45 degree fundus photograph. NIDEK AFC-230 fundus camera.
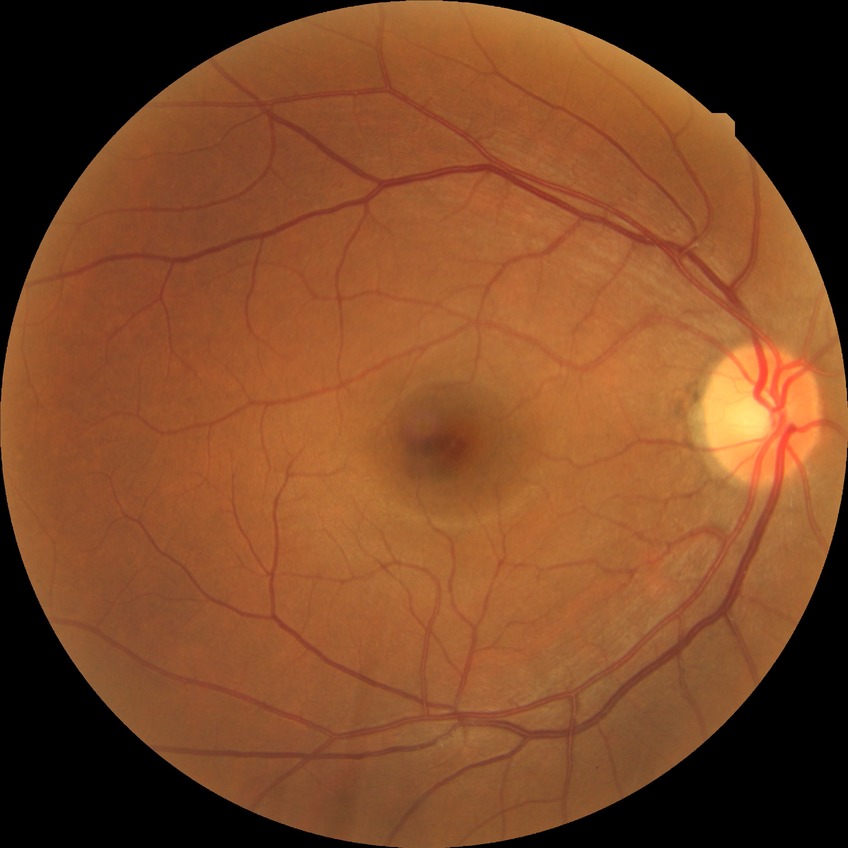
Modified Davis classification is no diabetic retinopathy.